Macula-centered field — 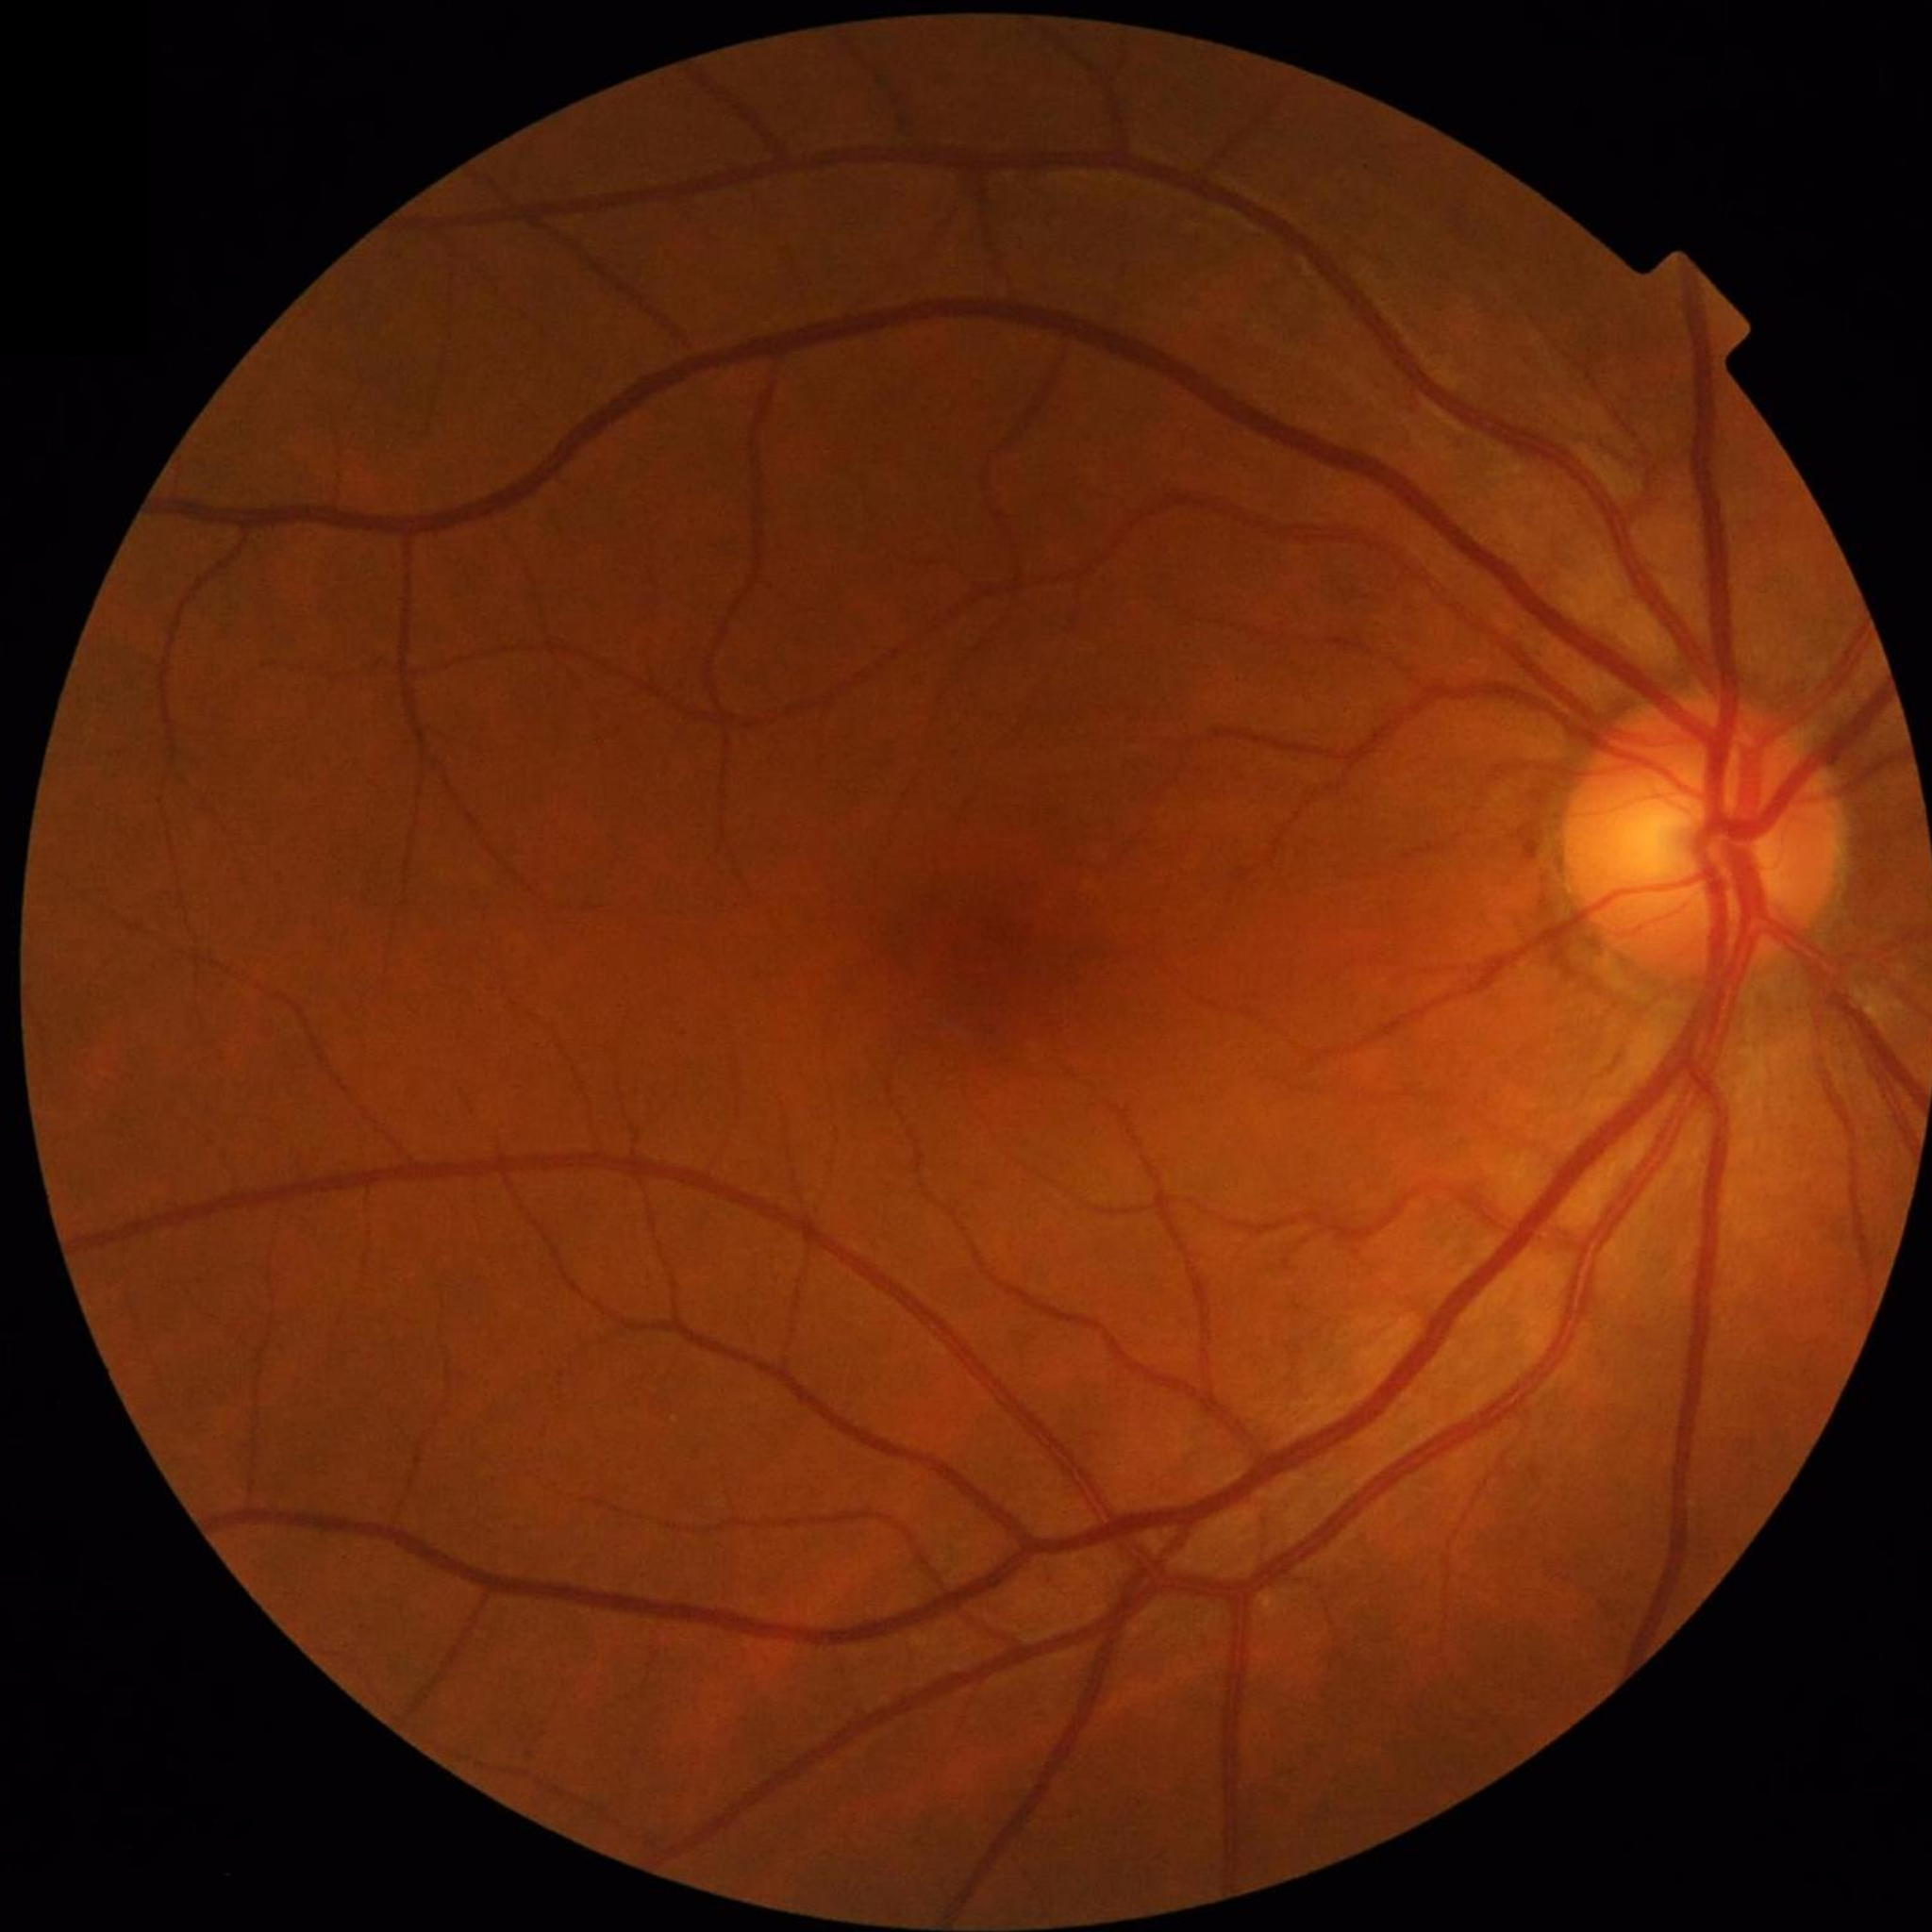 Fundus image with no AMD, diabetic retinopathy, or glaucomatous findings.